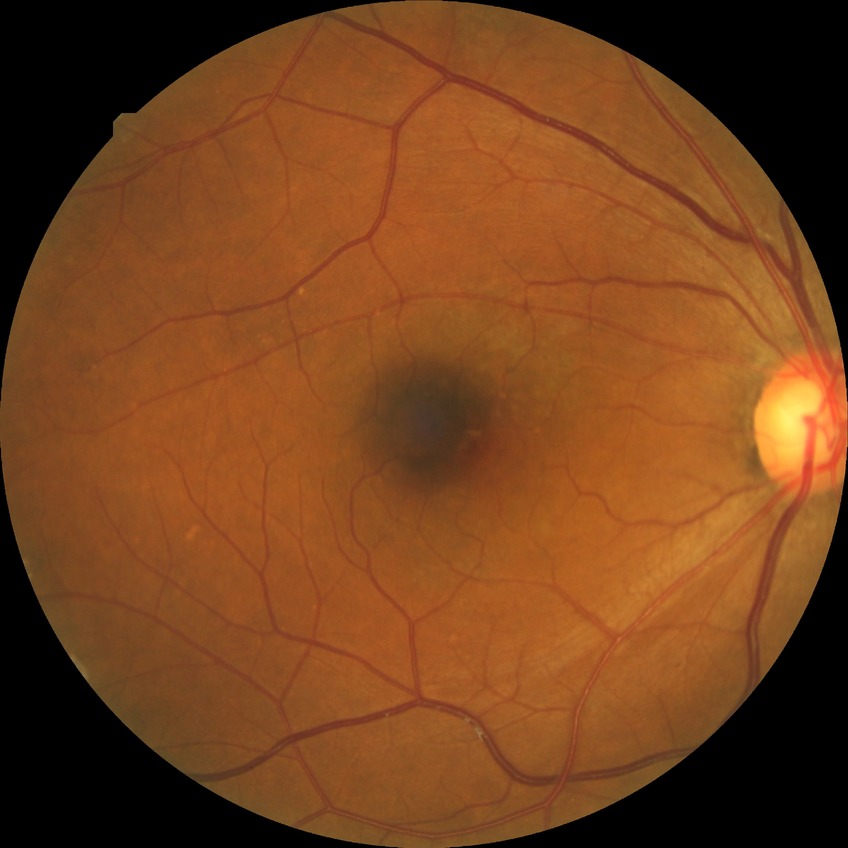
Diabetic retinopathy (DR) is no diabetic retinopathy (NDR).